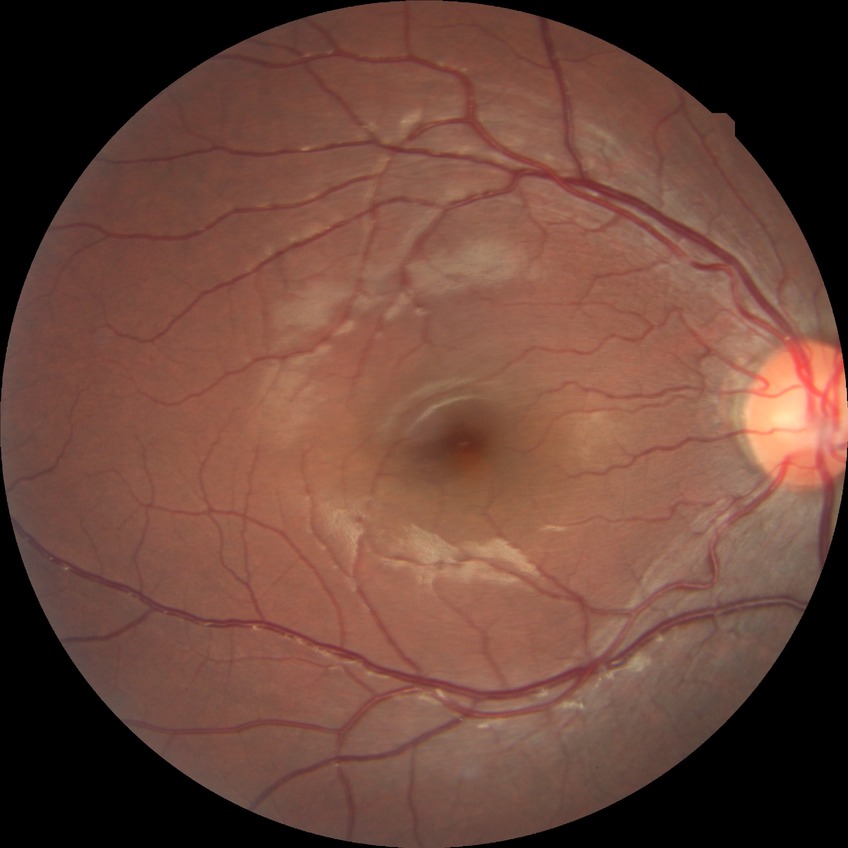 diabetic retinopathy (DR)=NDR (no diabetic retinopathy).